Wide-field fundus image from infant ROP screening; 130° field of view (Natus RetCam Envision); 1440 x 1080 pixels.
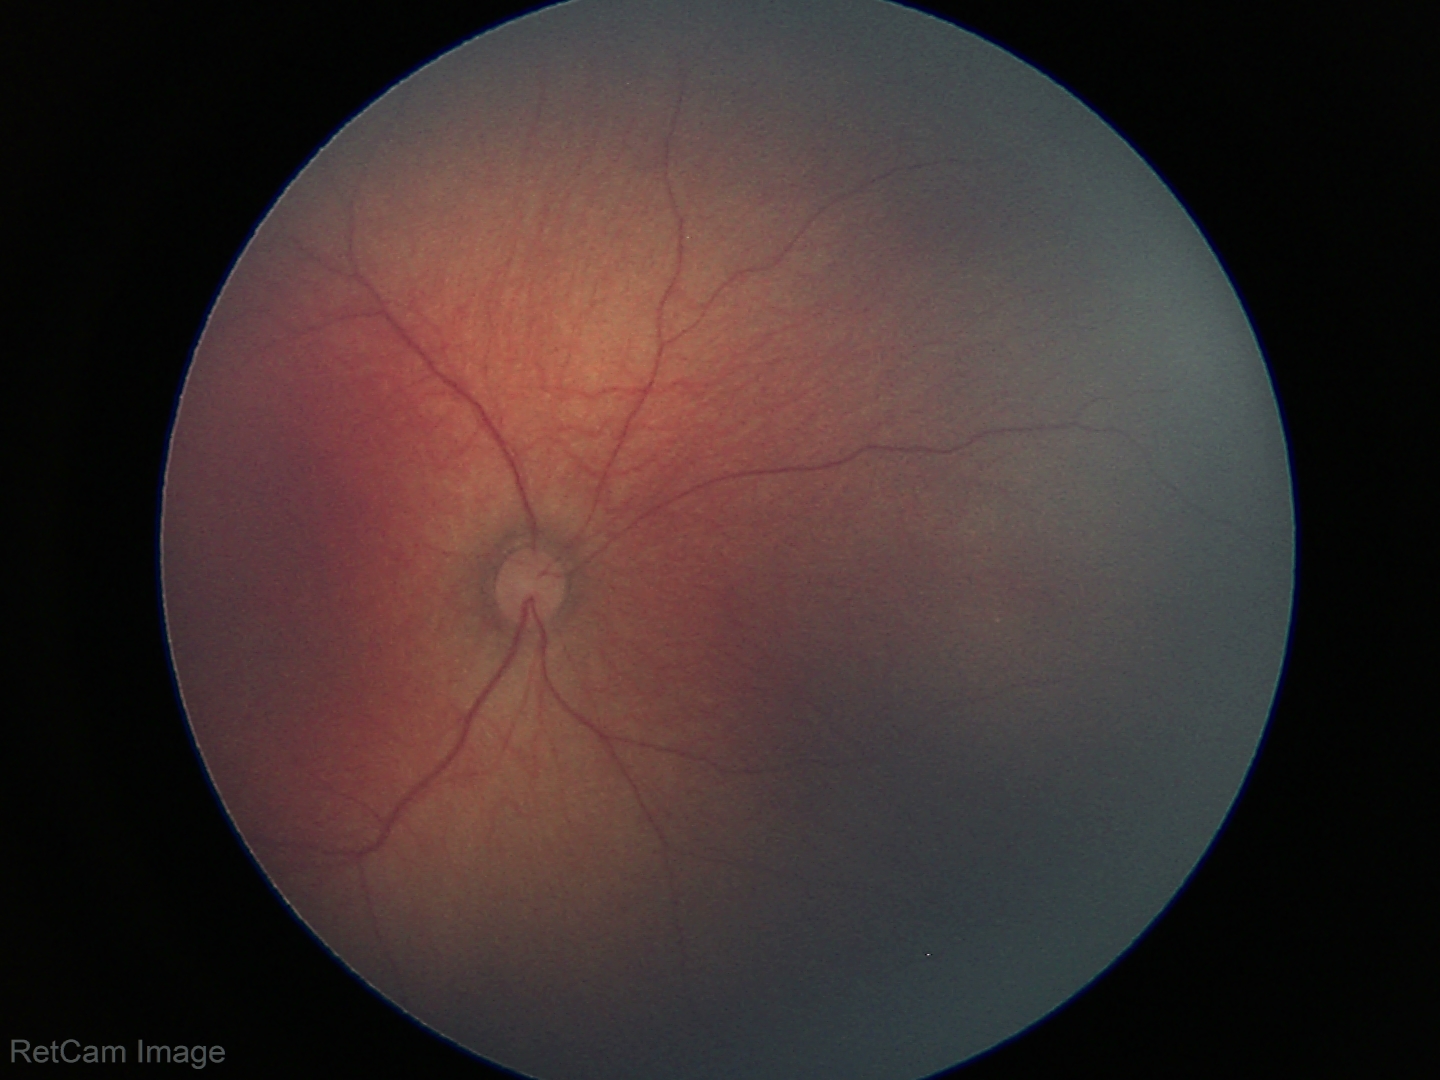 Physiological retinal appearance for postconceptual age.